Mydriatic acquisition. Optic disc region of a color fundus photo. 460x460.
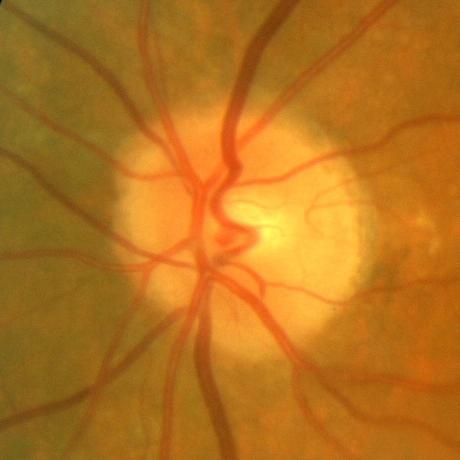 Glaucoma status = no evidence of glaucoma.